Acquired on the Phoenix ICON; Phoenix ICON wide-field infant fundus image:
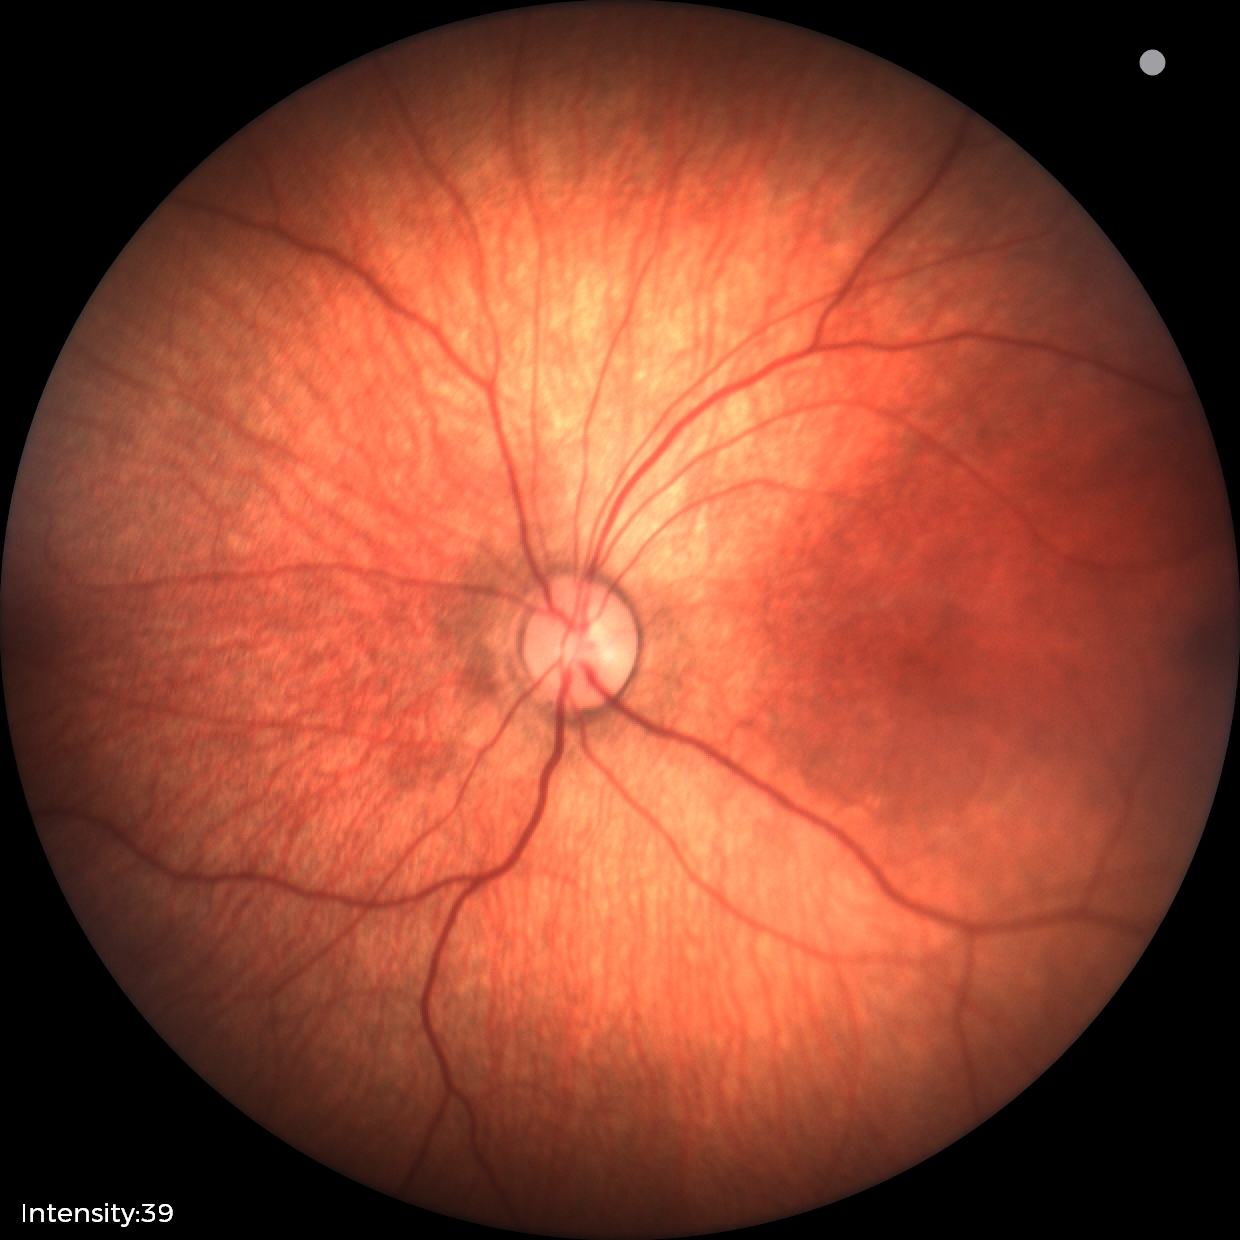
Finding = physiological.